2212x1672:
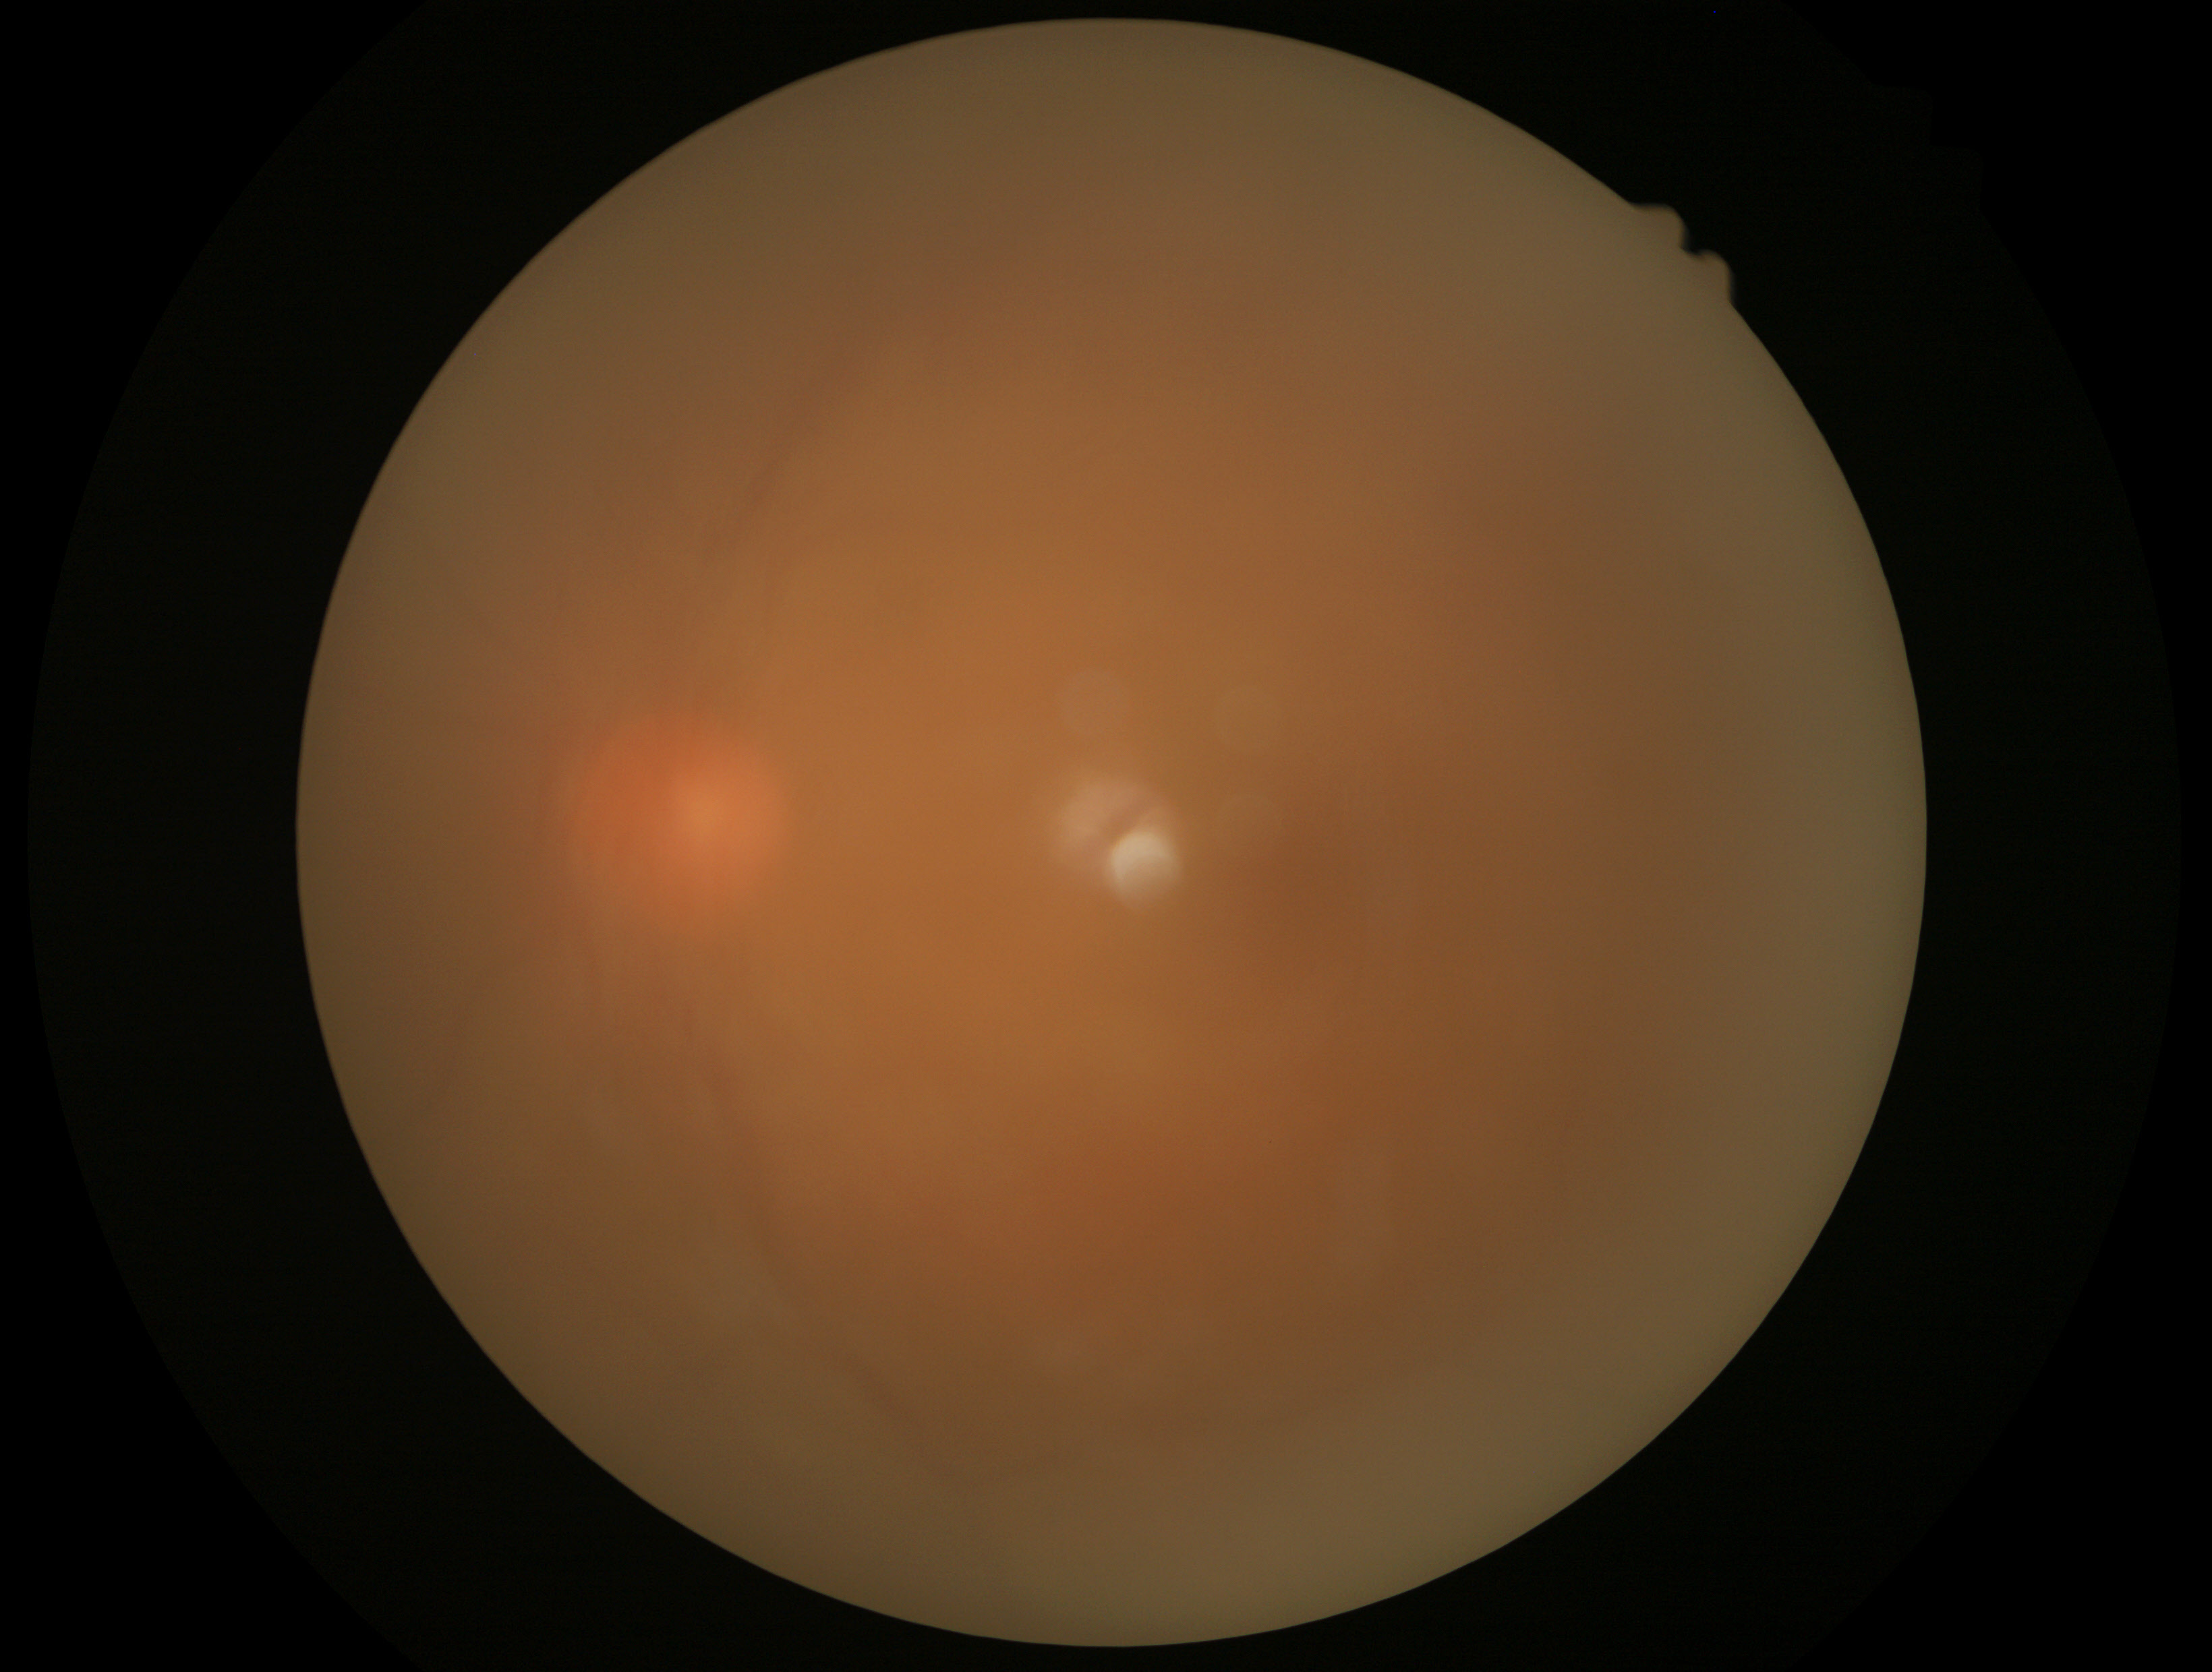

Image quality is insufficient for diabetic retinopathy assessment.
Retinopathy grade is ungradable.